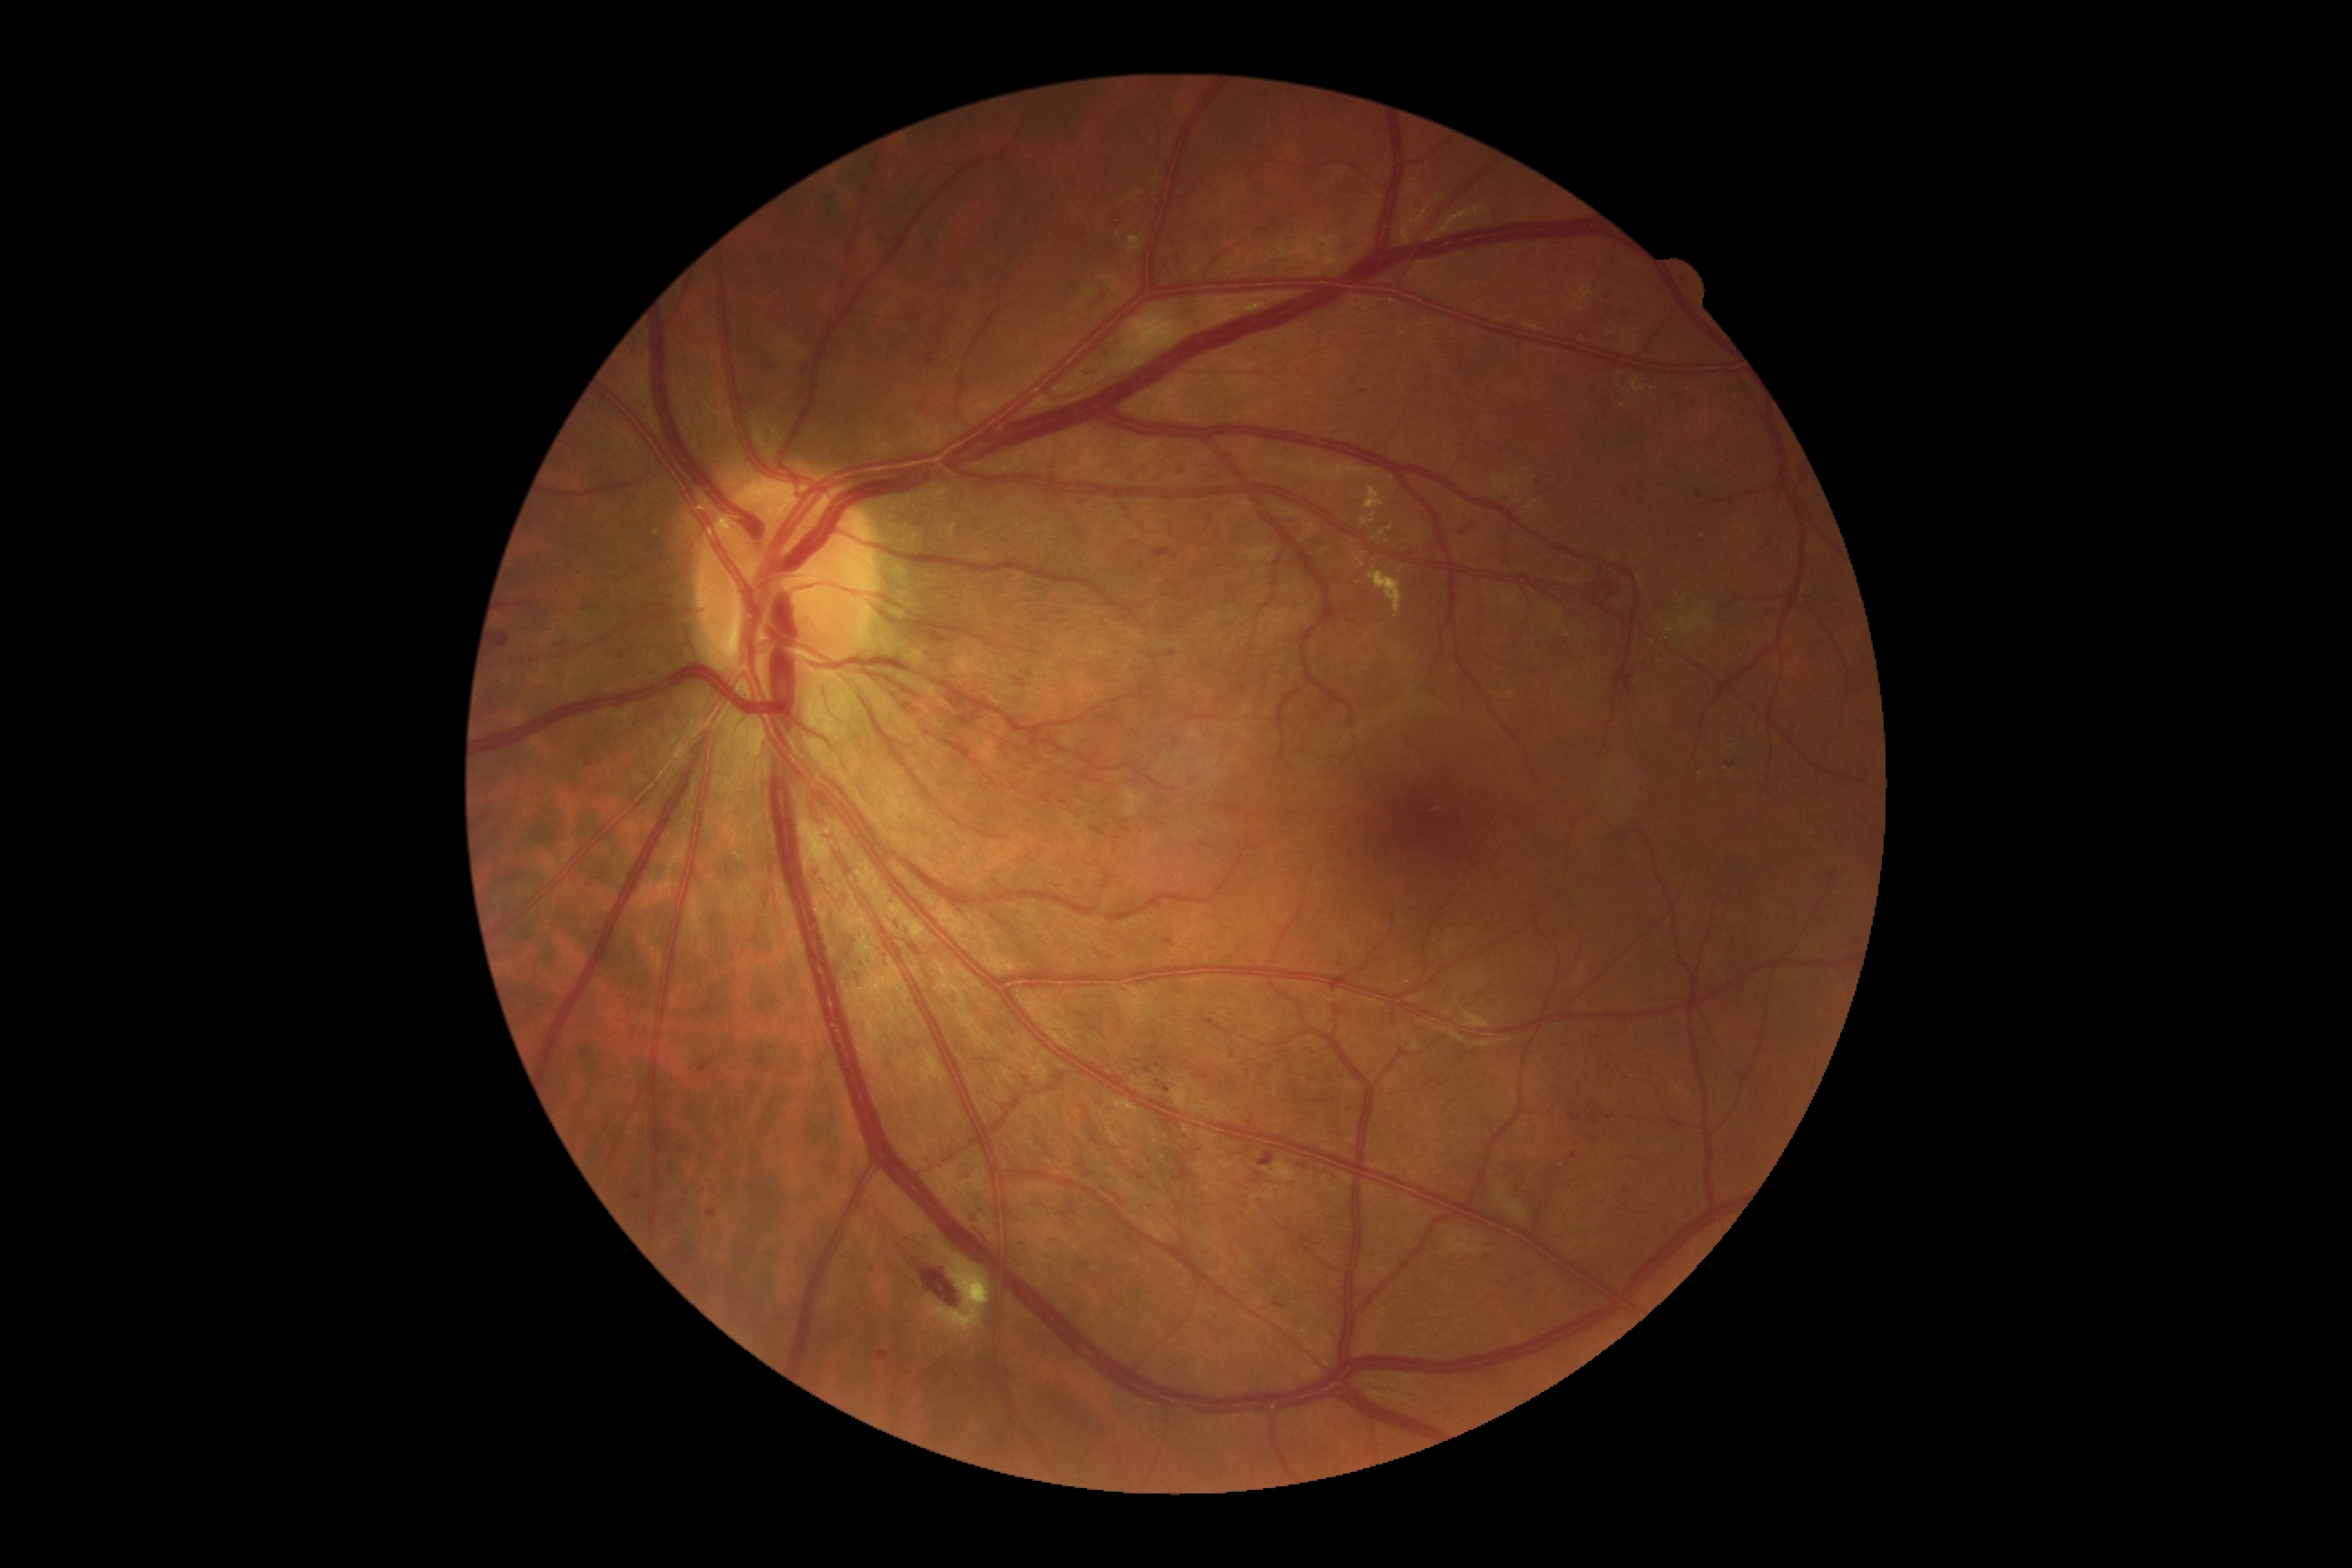

Diabetic retinopathy: 2/4
A subset of detected lesions:
hemorrhages (partial) = 1340,244,1351,251; 703,1001,721,1015; 816,190,838,208; 957,1171,974,1179; 1602,291,1612,300; 1431,1244,1440,1251; 1153,549,1171,558; 896,1239,963,1309; 1273,1300,1286,1309; 767,364,778,377; 707,1210,716,1219; 652,583,660,589; 923,1233,934,1242; 554,643,573,651; 627,716,647,727
Smaller hemorrhages around [1158,1065]; [621,657]; [1167,1089]; [1248,1071]; [585,609]
hard exudates (partial) = 1262,1161,1302,1182; 1362,511,1378,527; 1369,567,1404,618; 1124,790,1146,816; 1364,487,1386,511; 652,529,660,540; 1631,380,1647,393; 1355,553,1366,569; 1446,1230,1485,1257; 1375,529,1386,542; 928,1257,990,1335; 1493,1190,1529,1222; 1128,235,1142,255
Smaller hard exudates around [1652,389]; [1623,406]; [1401,570]; [1392,528]; [1388,543]
microaneurysms = absent
soft exudates = absent